Acquired with a NIDEK AFC-230: 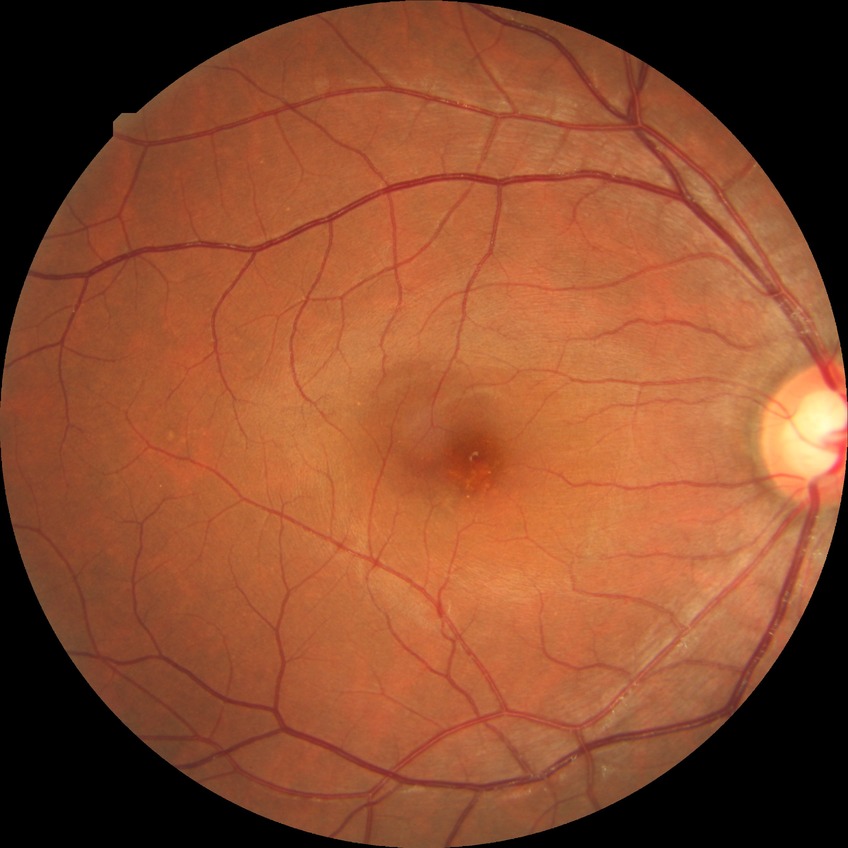
Diabetic retinopathy (DR): no diabetic retinopathy (NDR).